45° FOV. Image size 2048x1536:
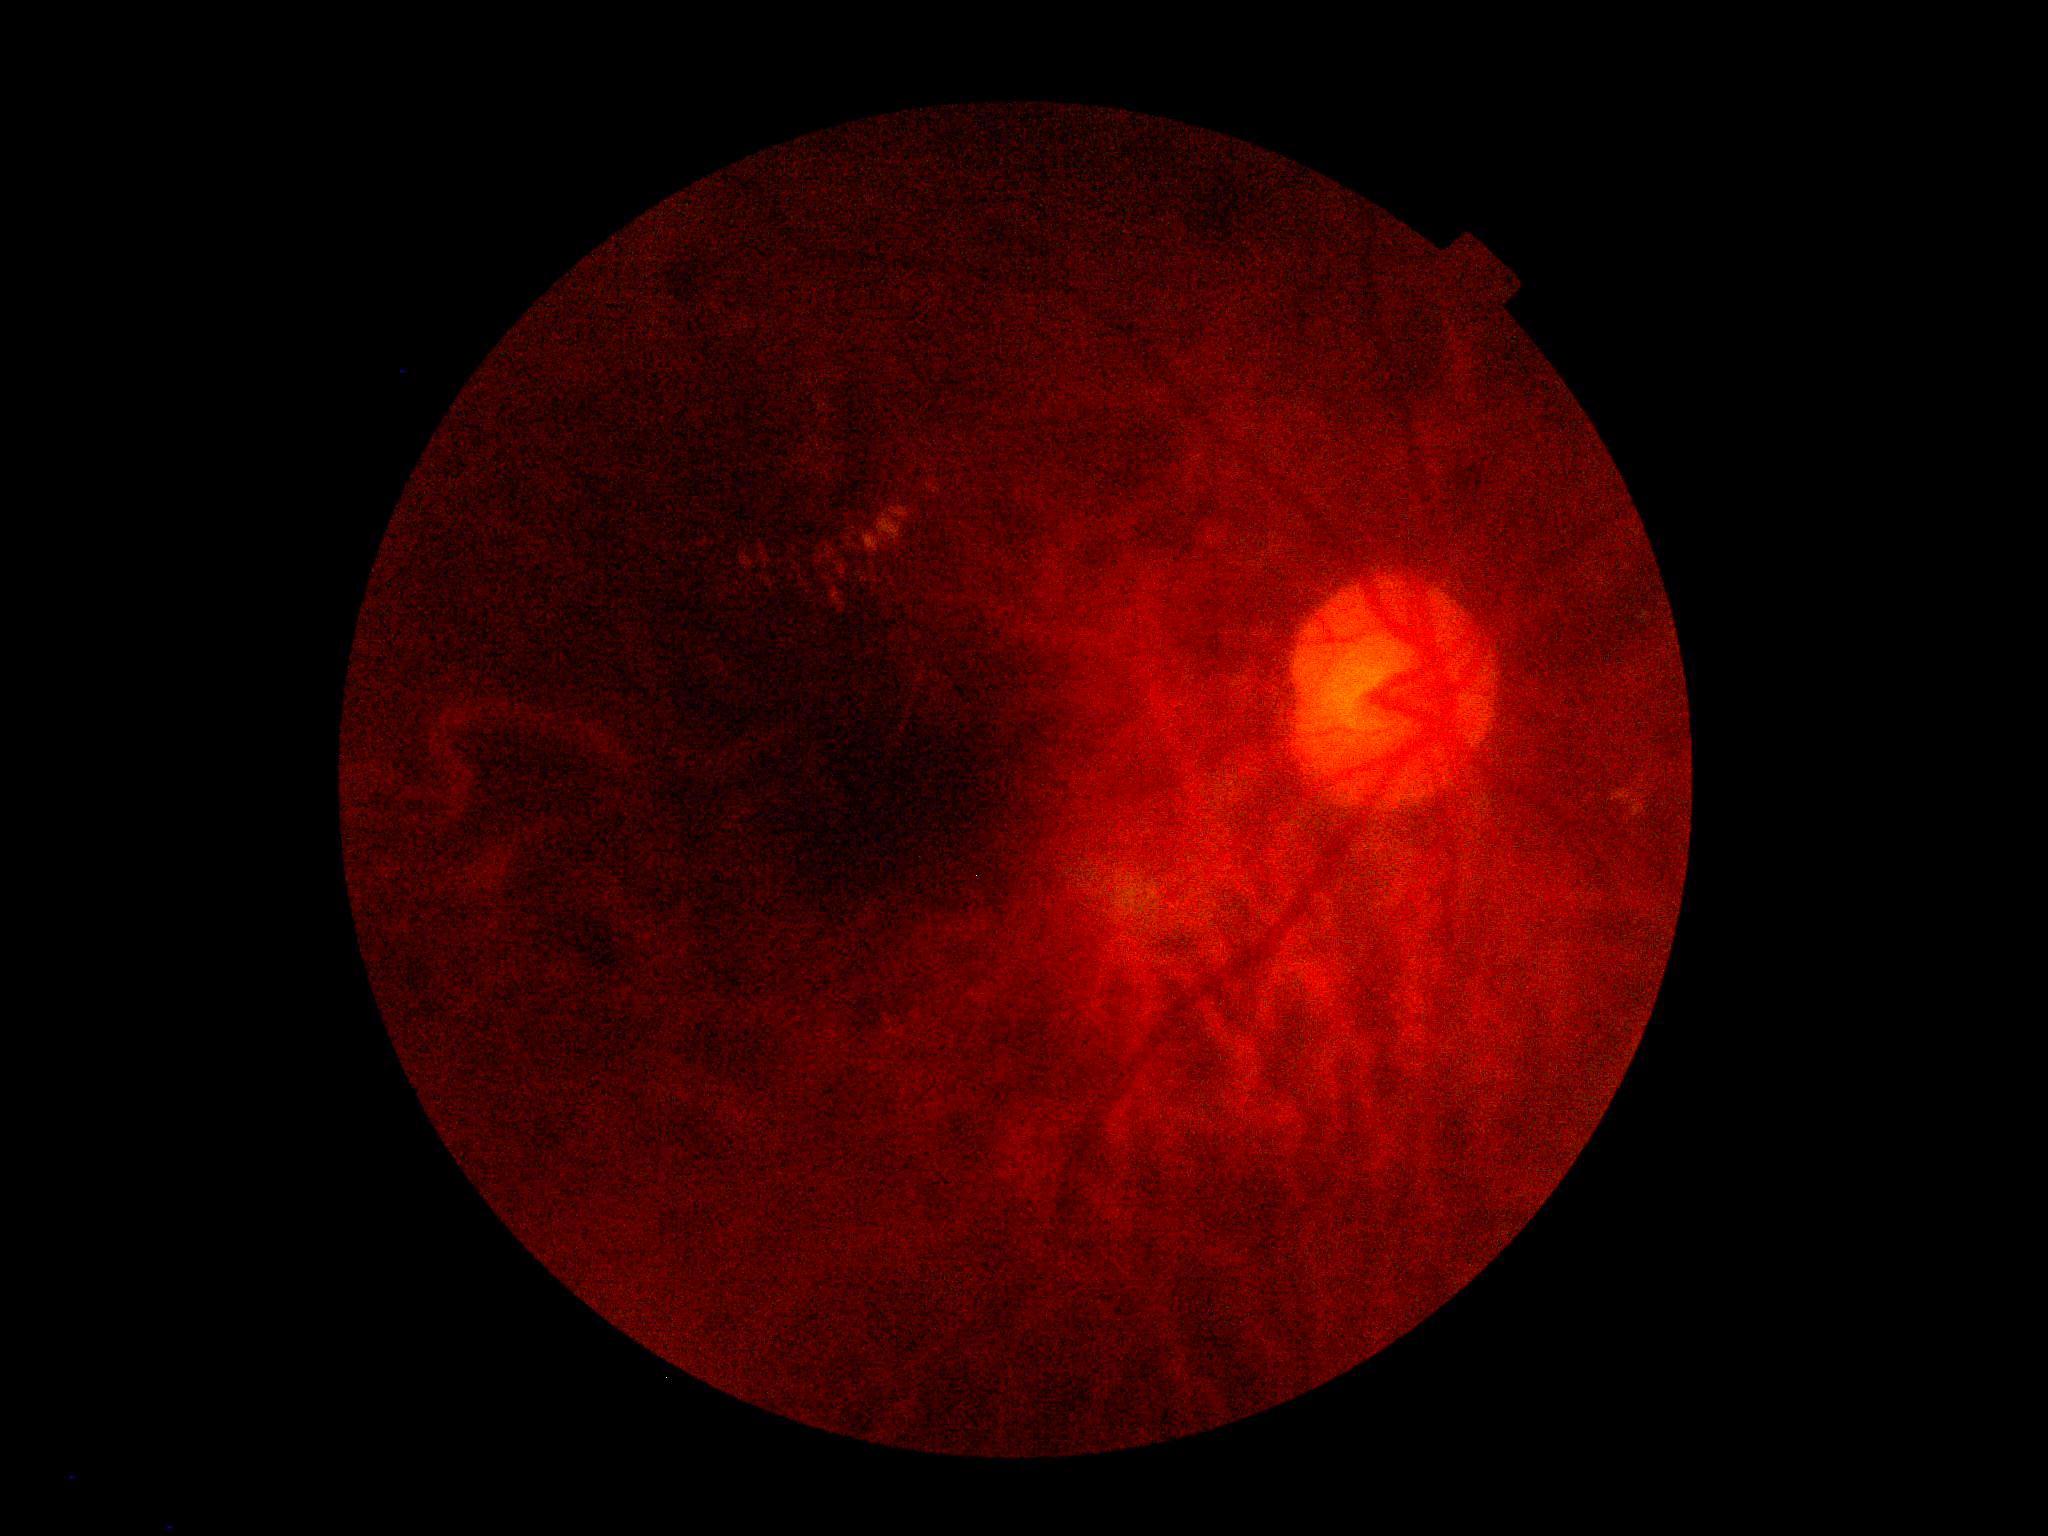

diabetic retinopathy grade=2 (moderate NPDR) — more than just microaneurysms but less than severe NPDR.